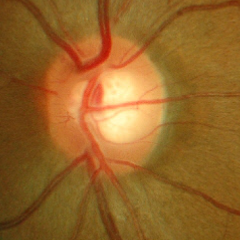 No glaucomatous optic neuropathy.